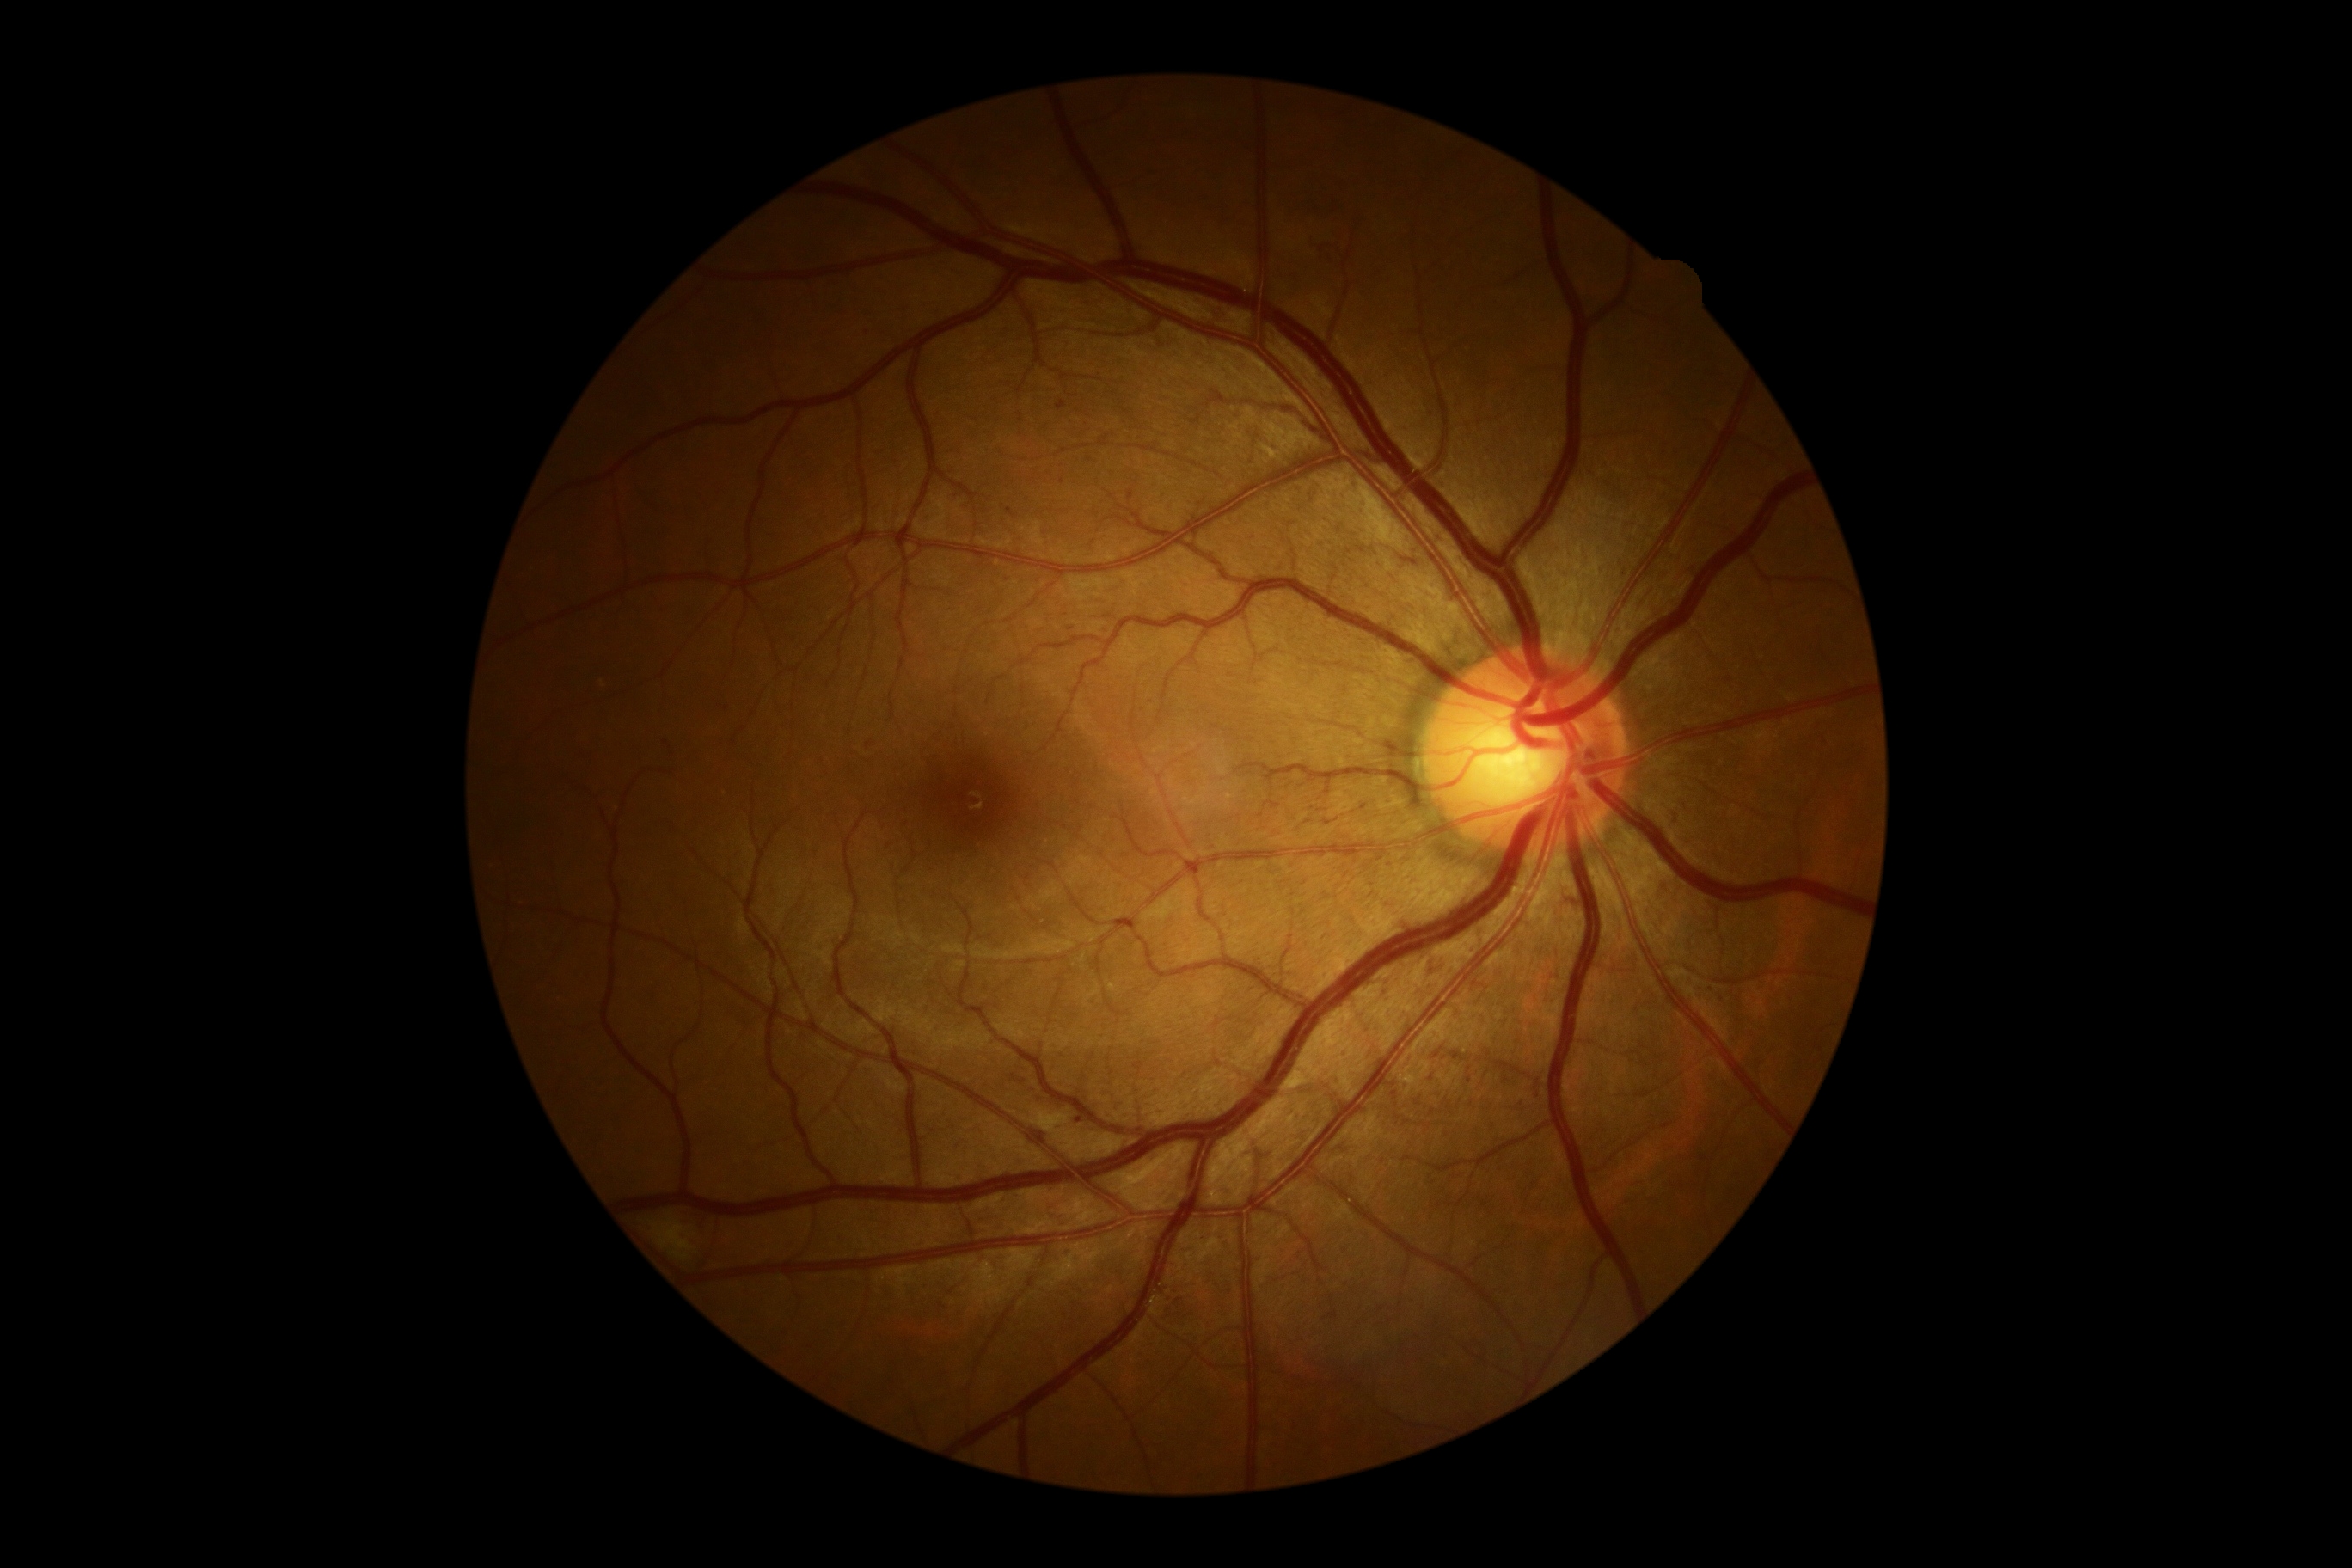   dr_grade: moderate NPDR (grade 2)